Nonmydriatic fundus photograph; FOV: 45 degrees:
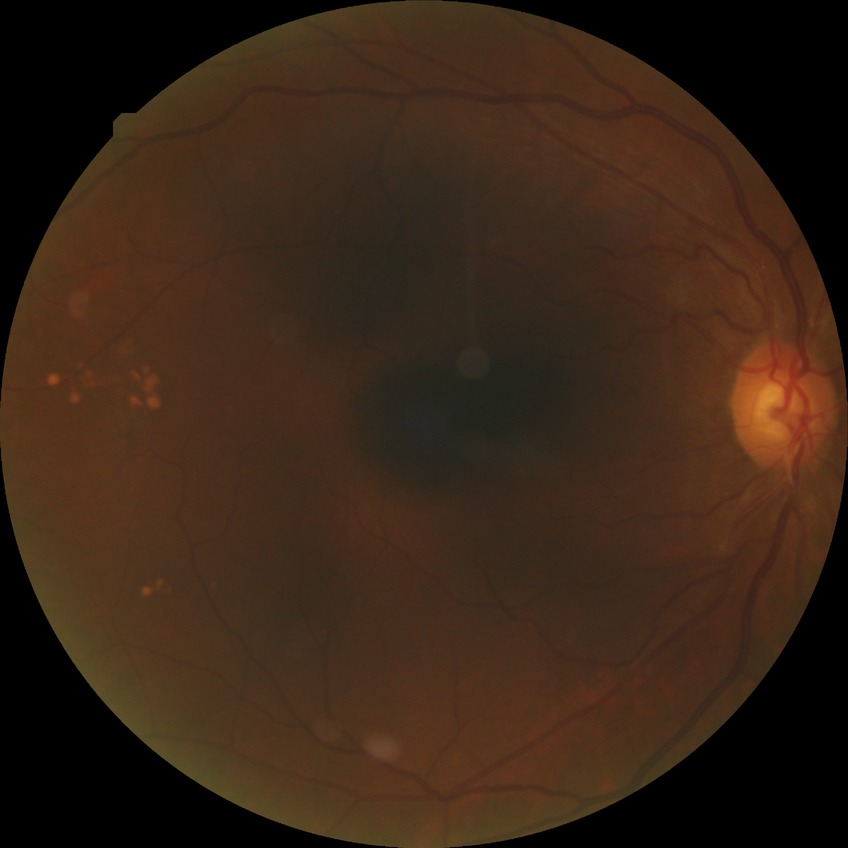

Diabetic retinopathy (DR): no diabetic retinopathy (NDR).